Image size 2346x1568: 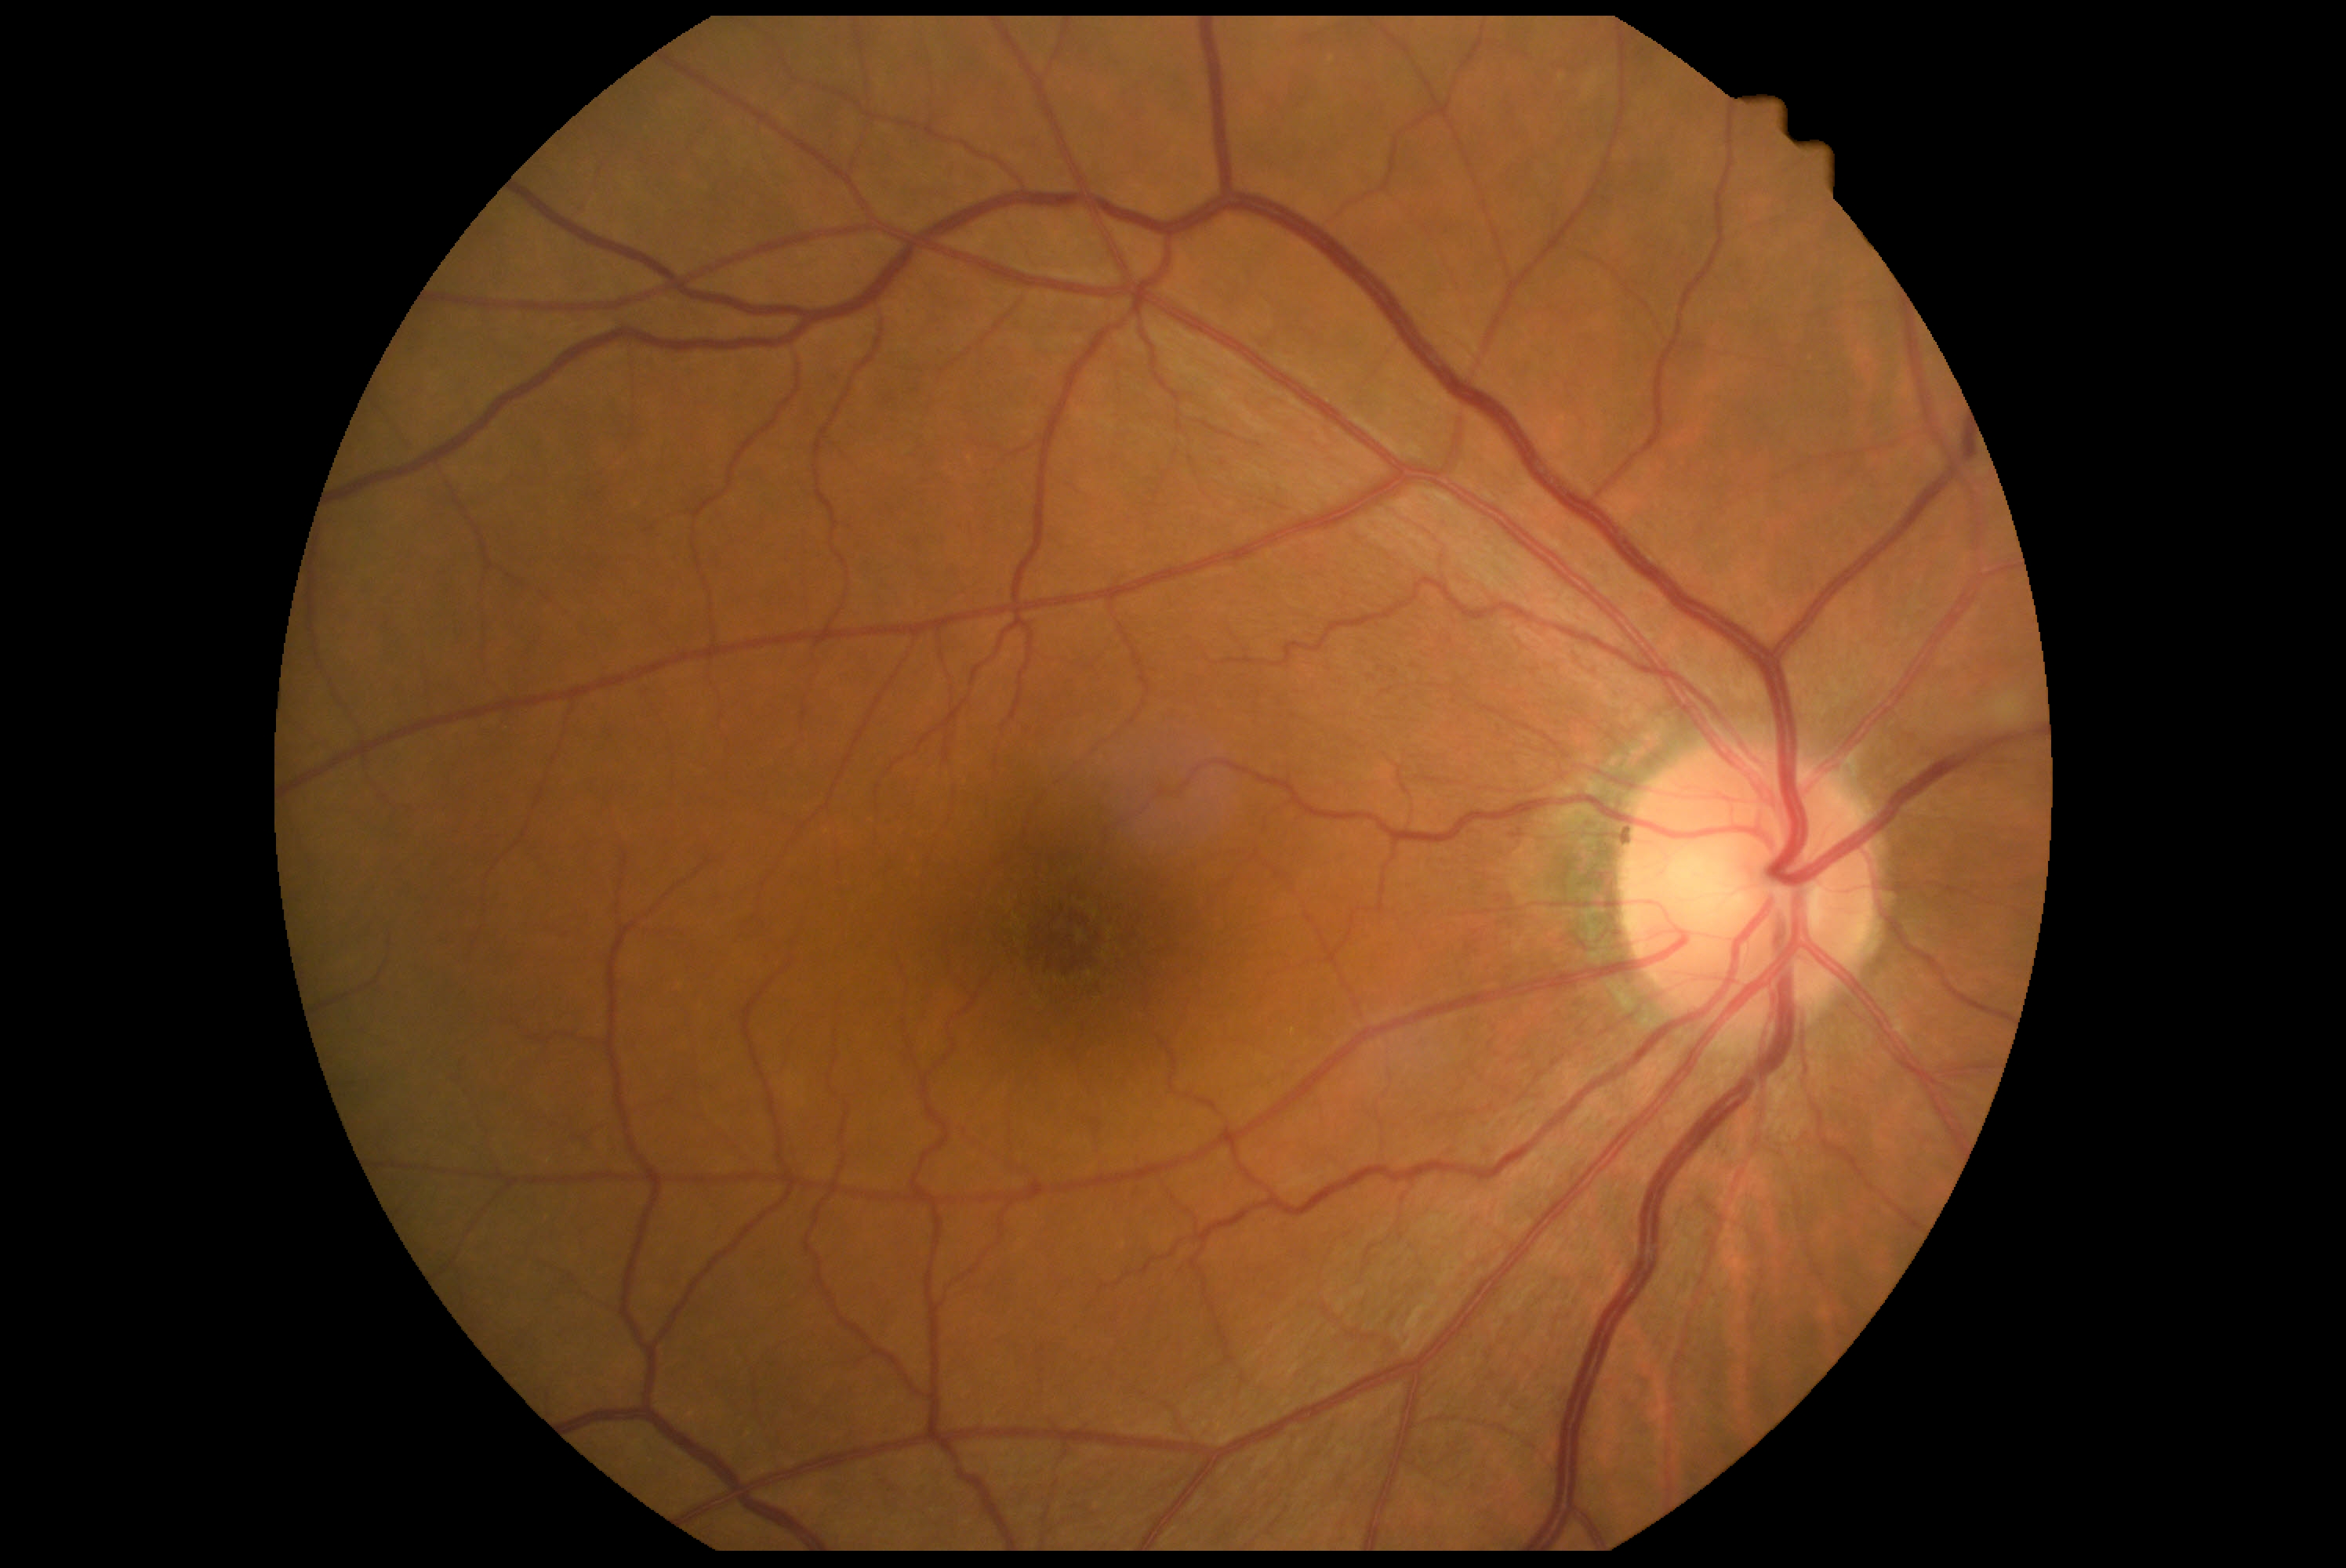

diabetic retinopathy: grade 0 (no apparent retinopathy) — no visible signs of diabetic retinopathy.